2352x1568:
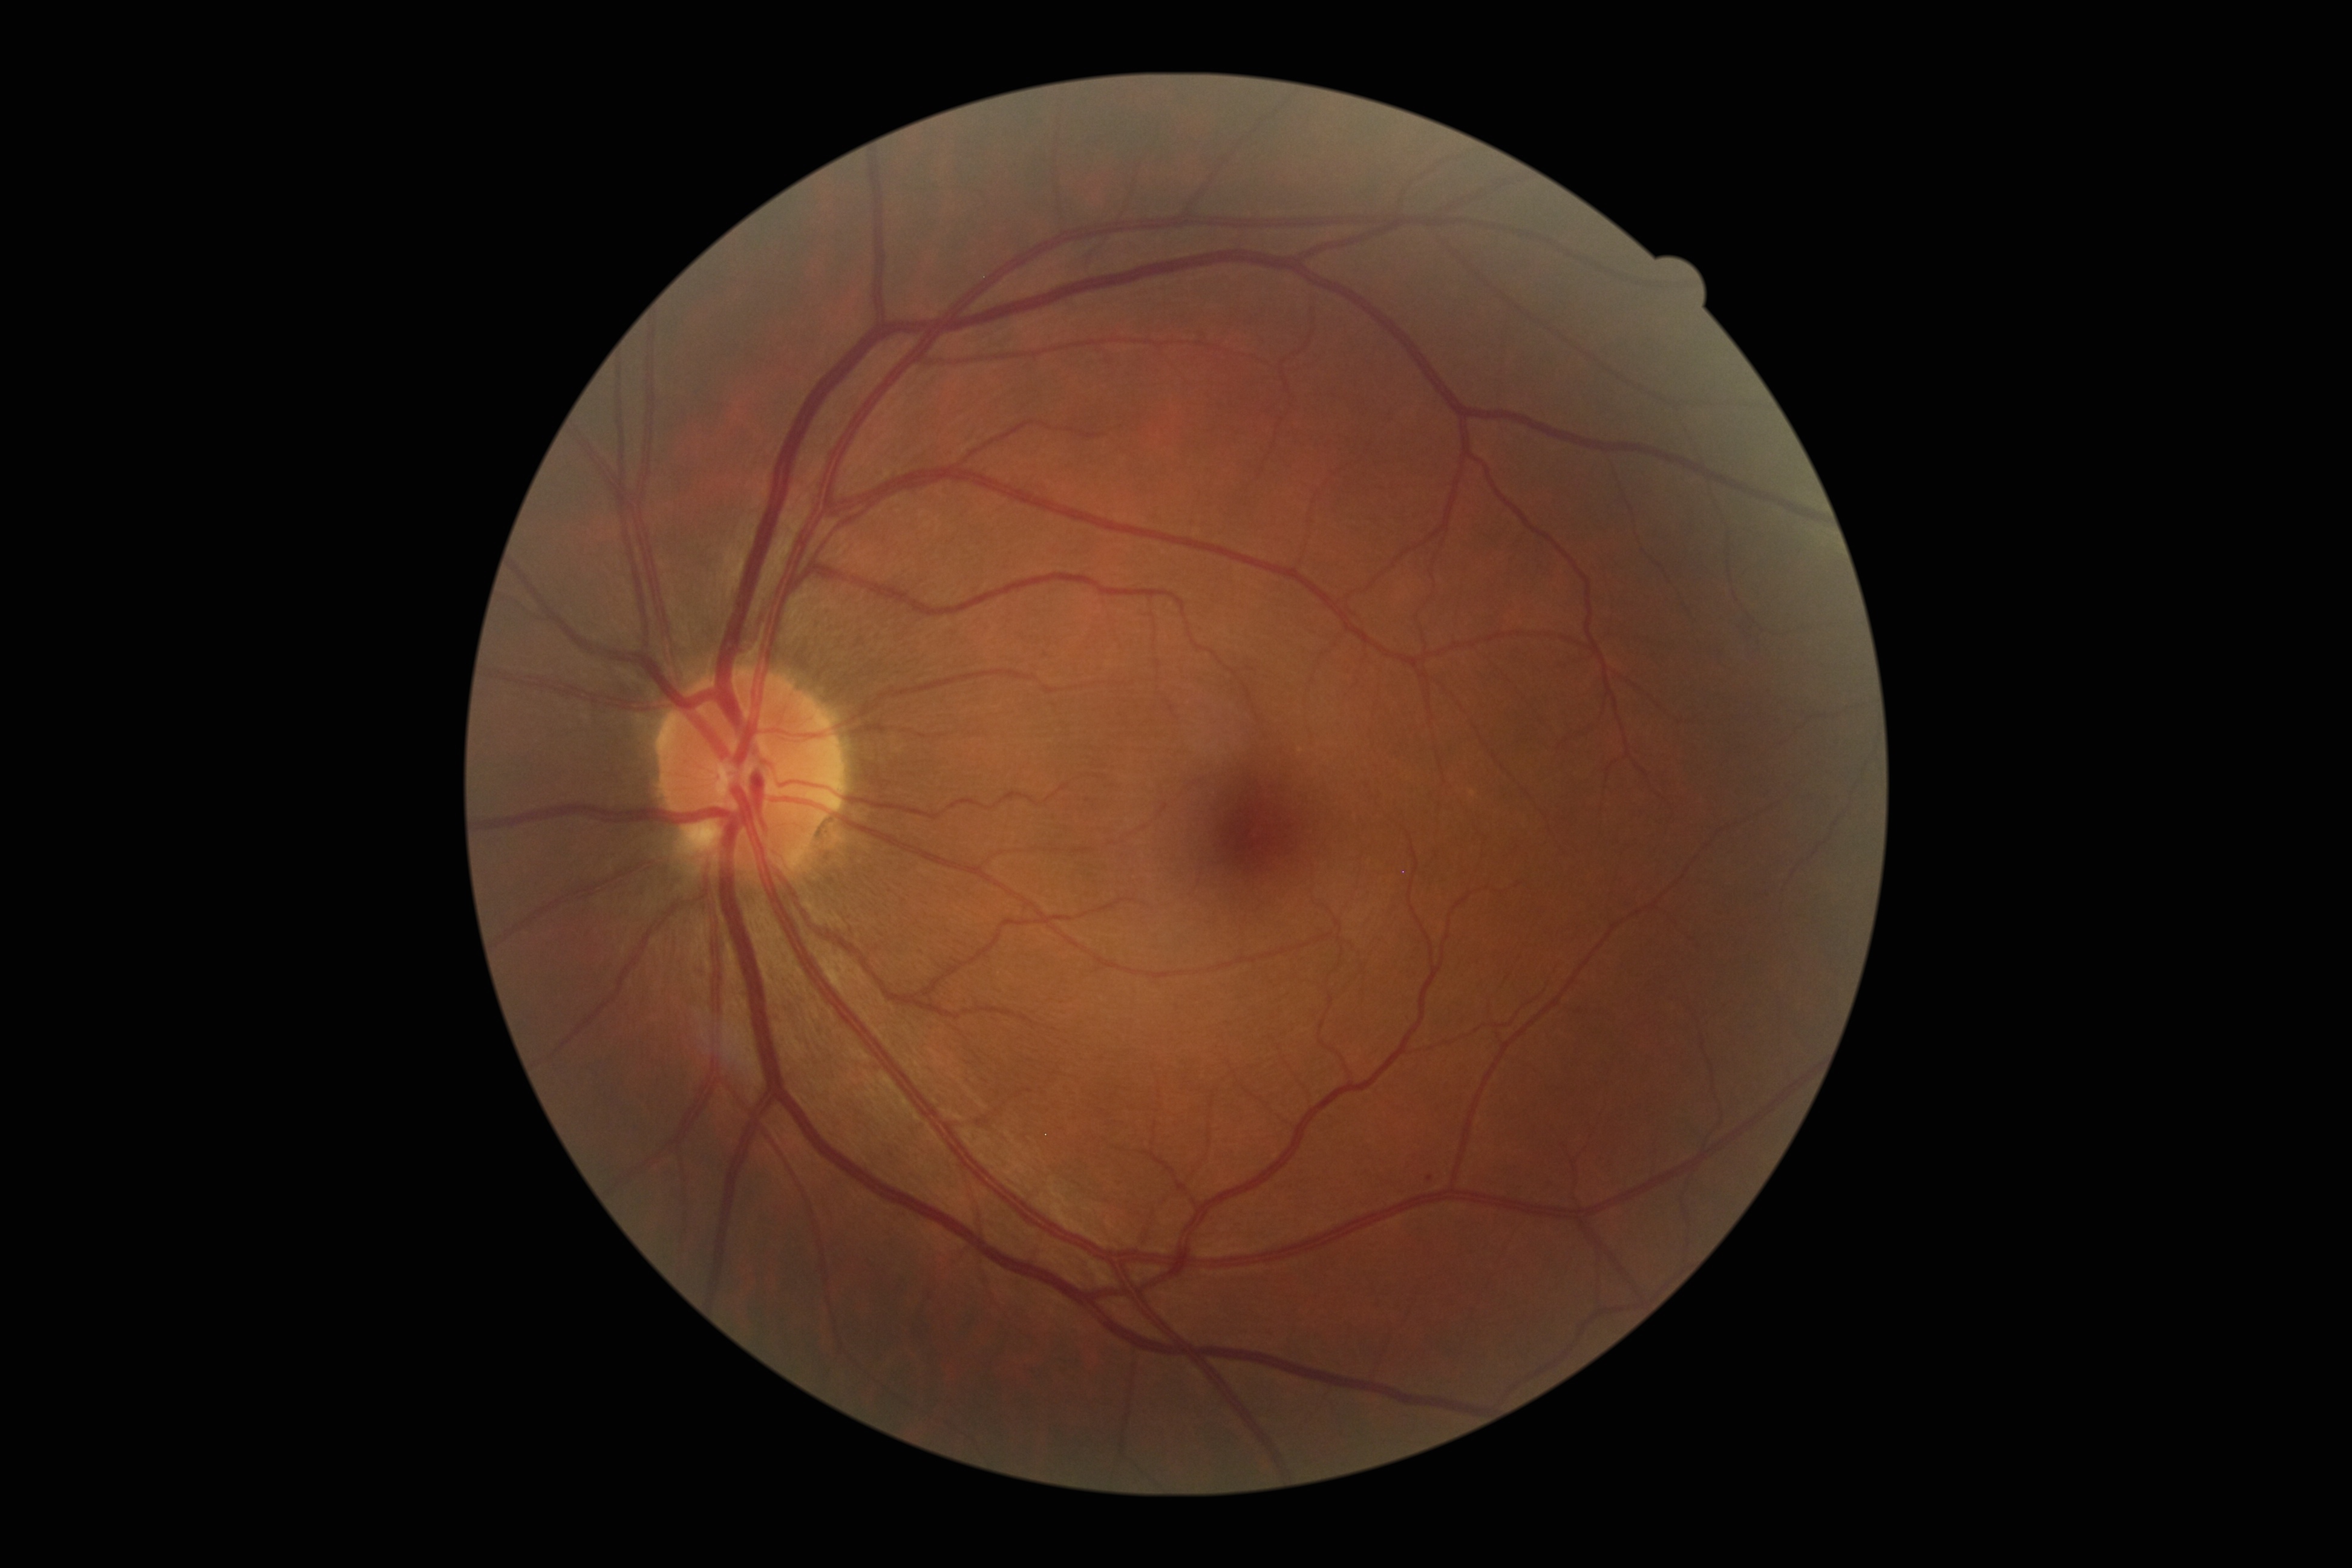

DR grade: 1, DR class: non-proliferative diabetic retinopathy.